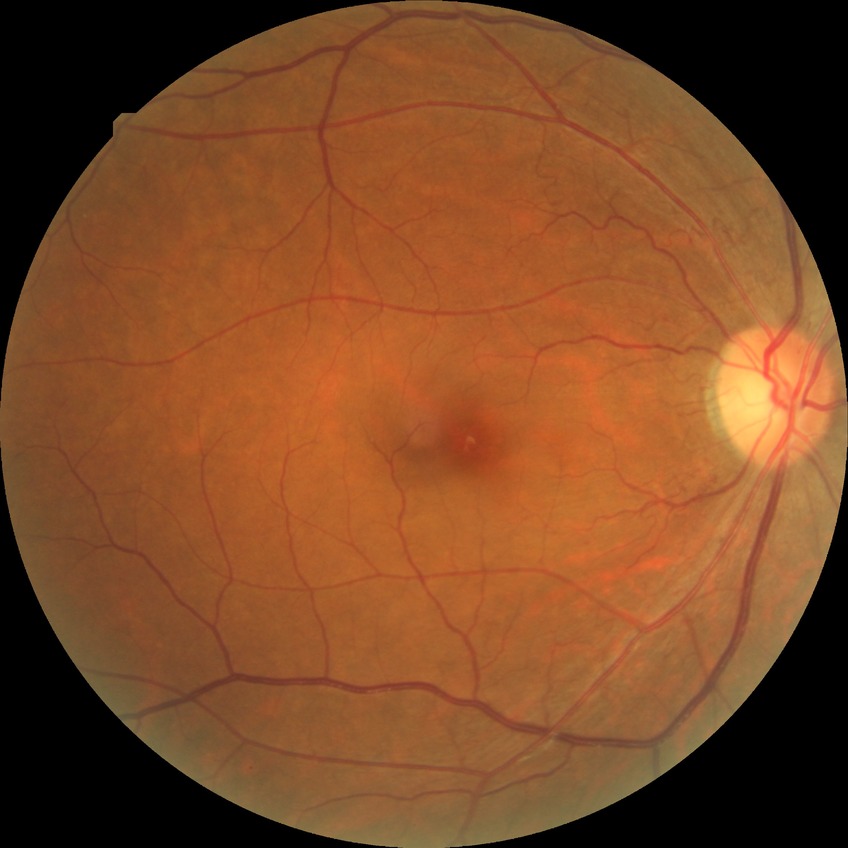 diabetic retinopathy (DR)=NDR (no diabetic retinopathy).